Central posterior field; image size 2228x1652:
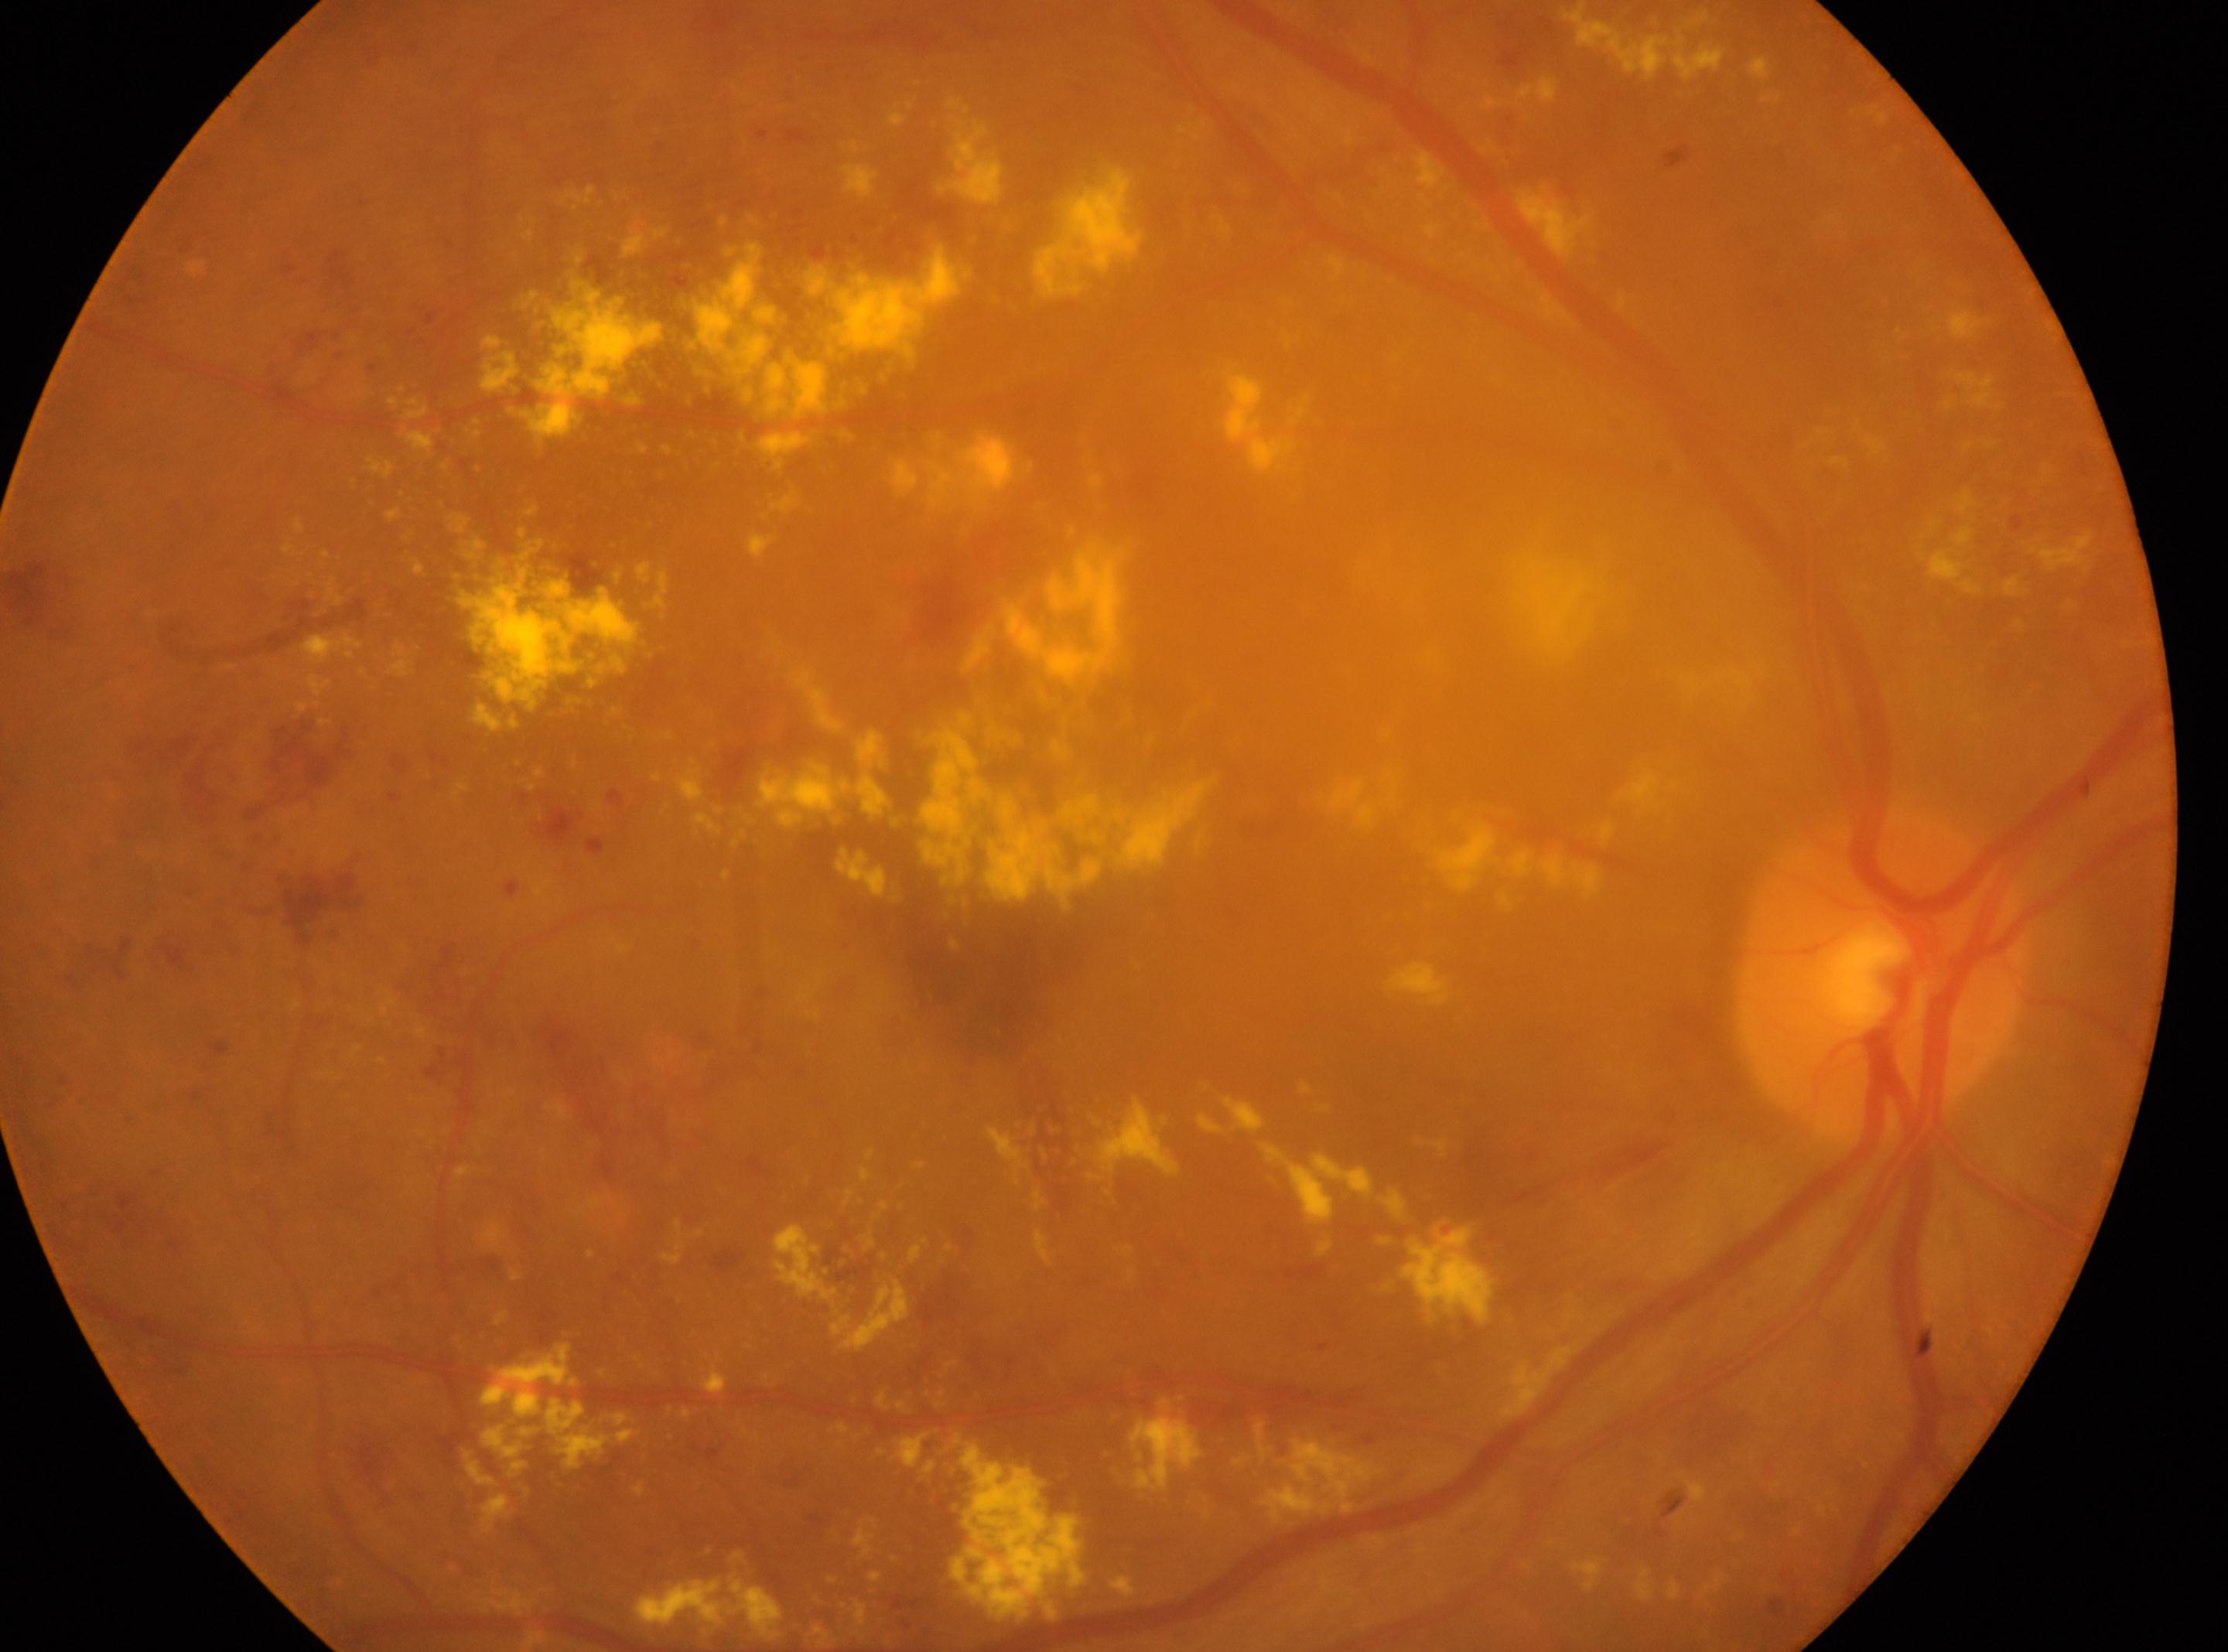
Eye: oculus dexter.
DR class: non-proliferative diabetic retinopathy.
The optic disc center is at (x: 1880, y: 974).
The fovea center is at (x: 978, y: 961).
DR stage: grade 3.